Retinal fundus photograph. FOV: 45 degrees.
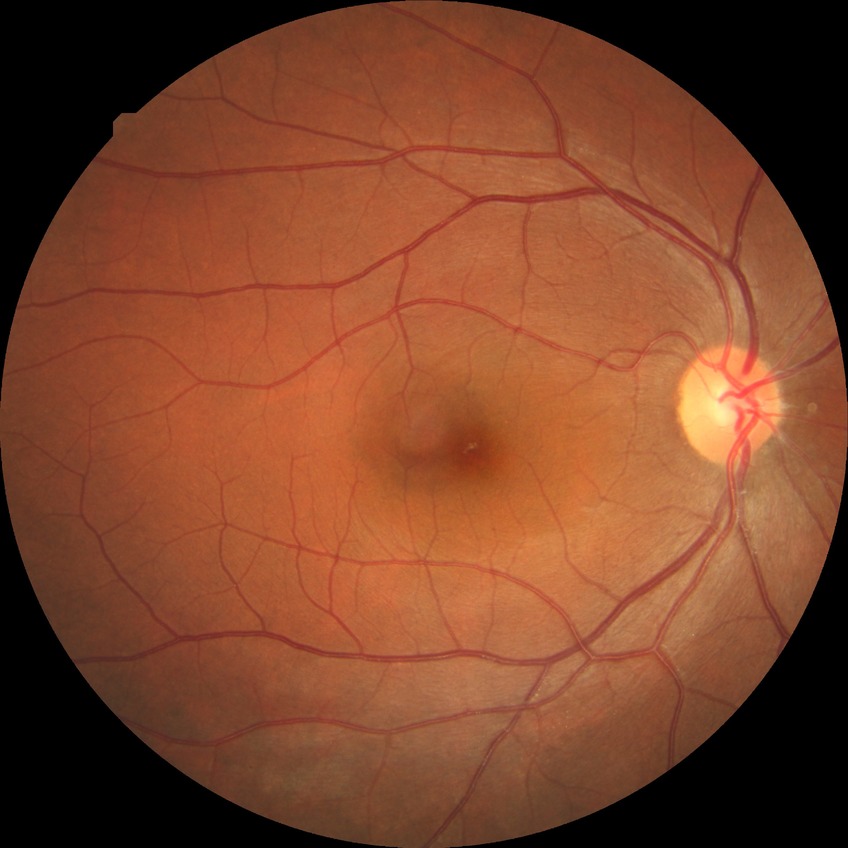 Assessment:
– modified Davis grading — no diabetic retinopathy